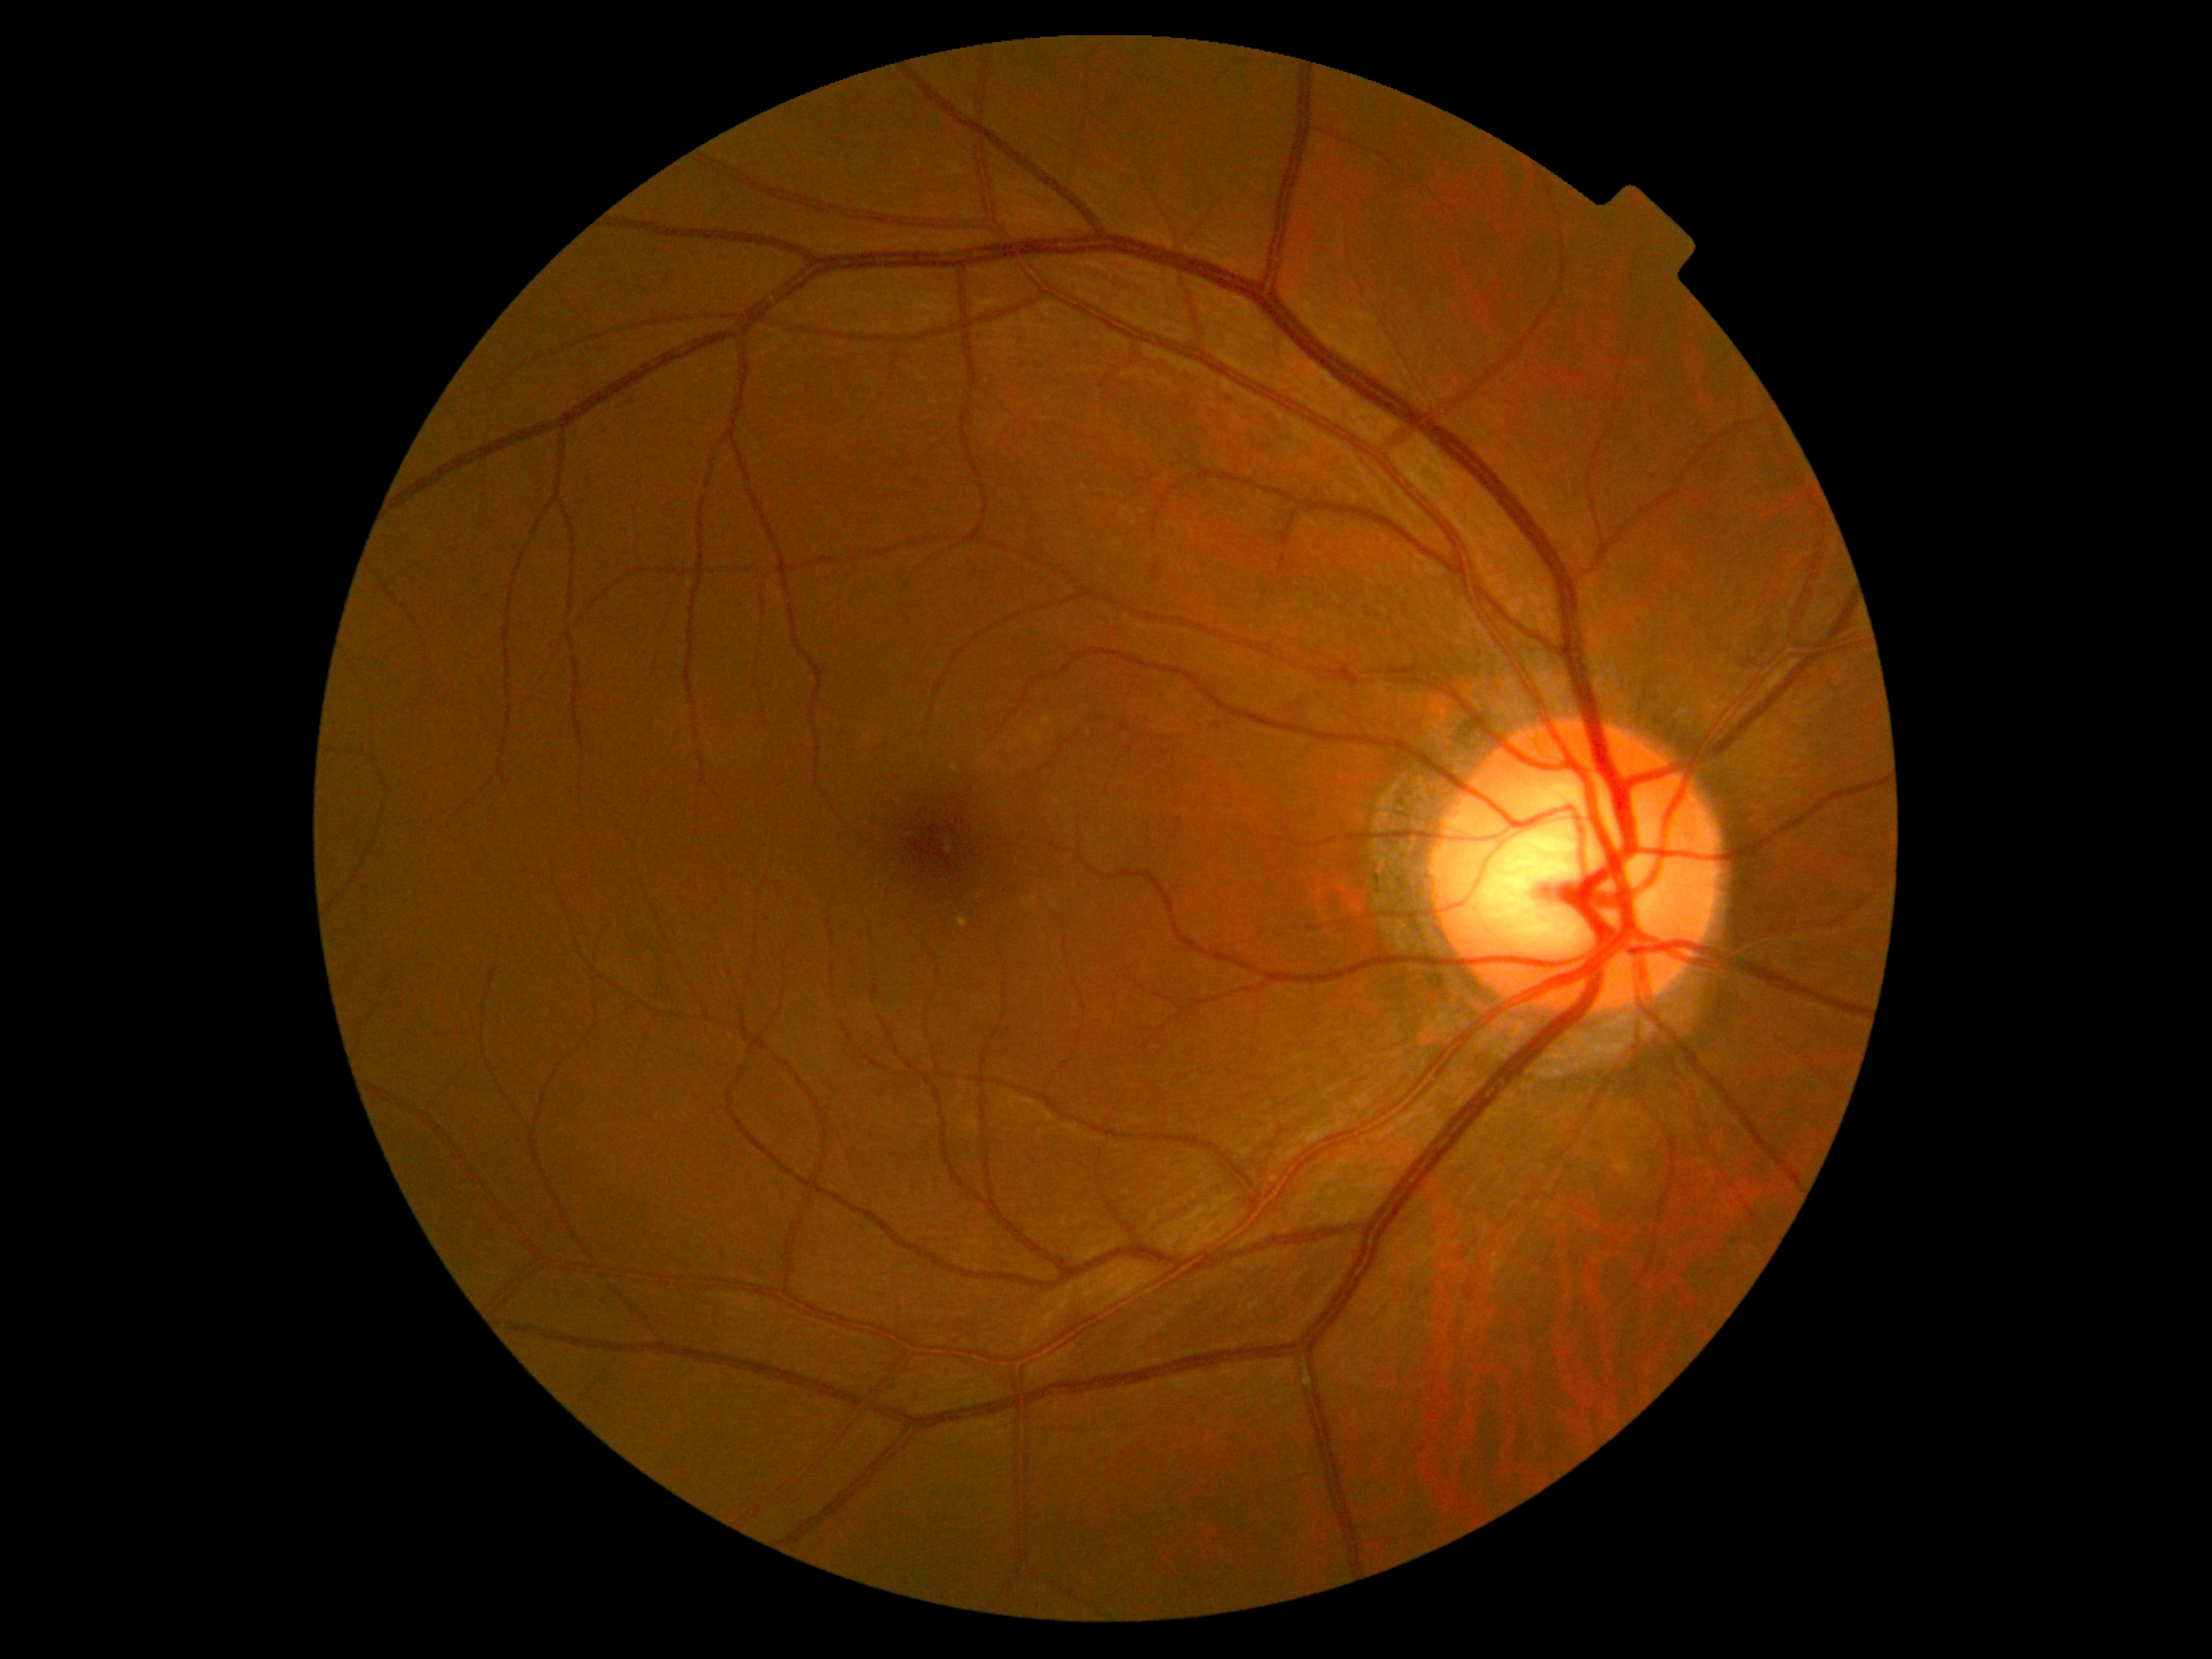
DR impression=no DR findings, diabetic retinopathy grade=0 — no visible signs of diabetic retinopathy.